45° FOV · 1932 by 1910 pixels.
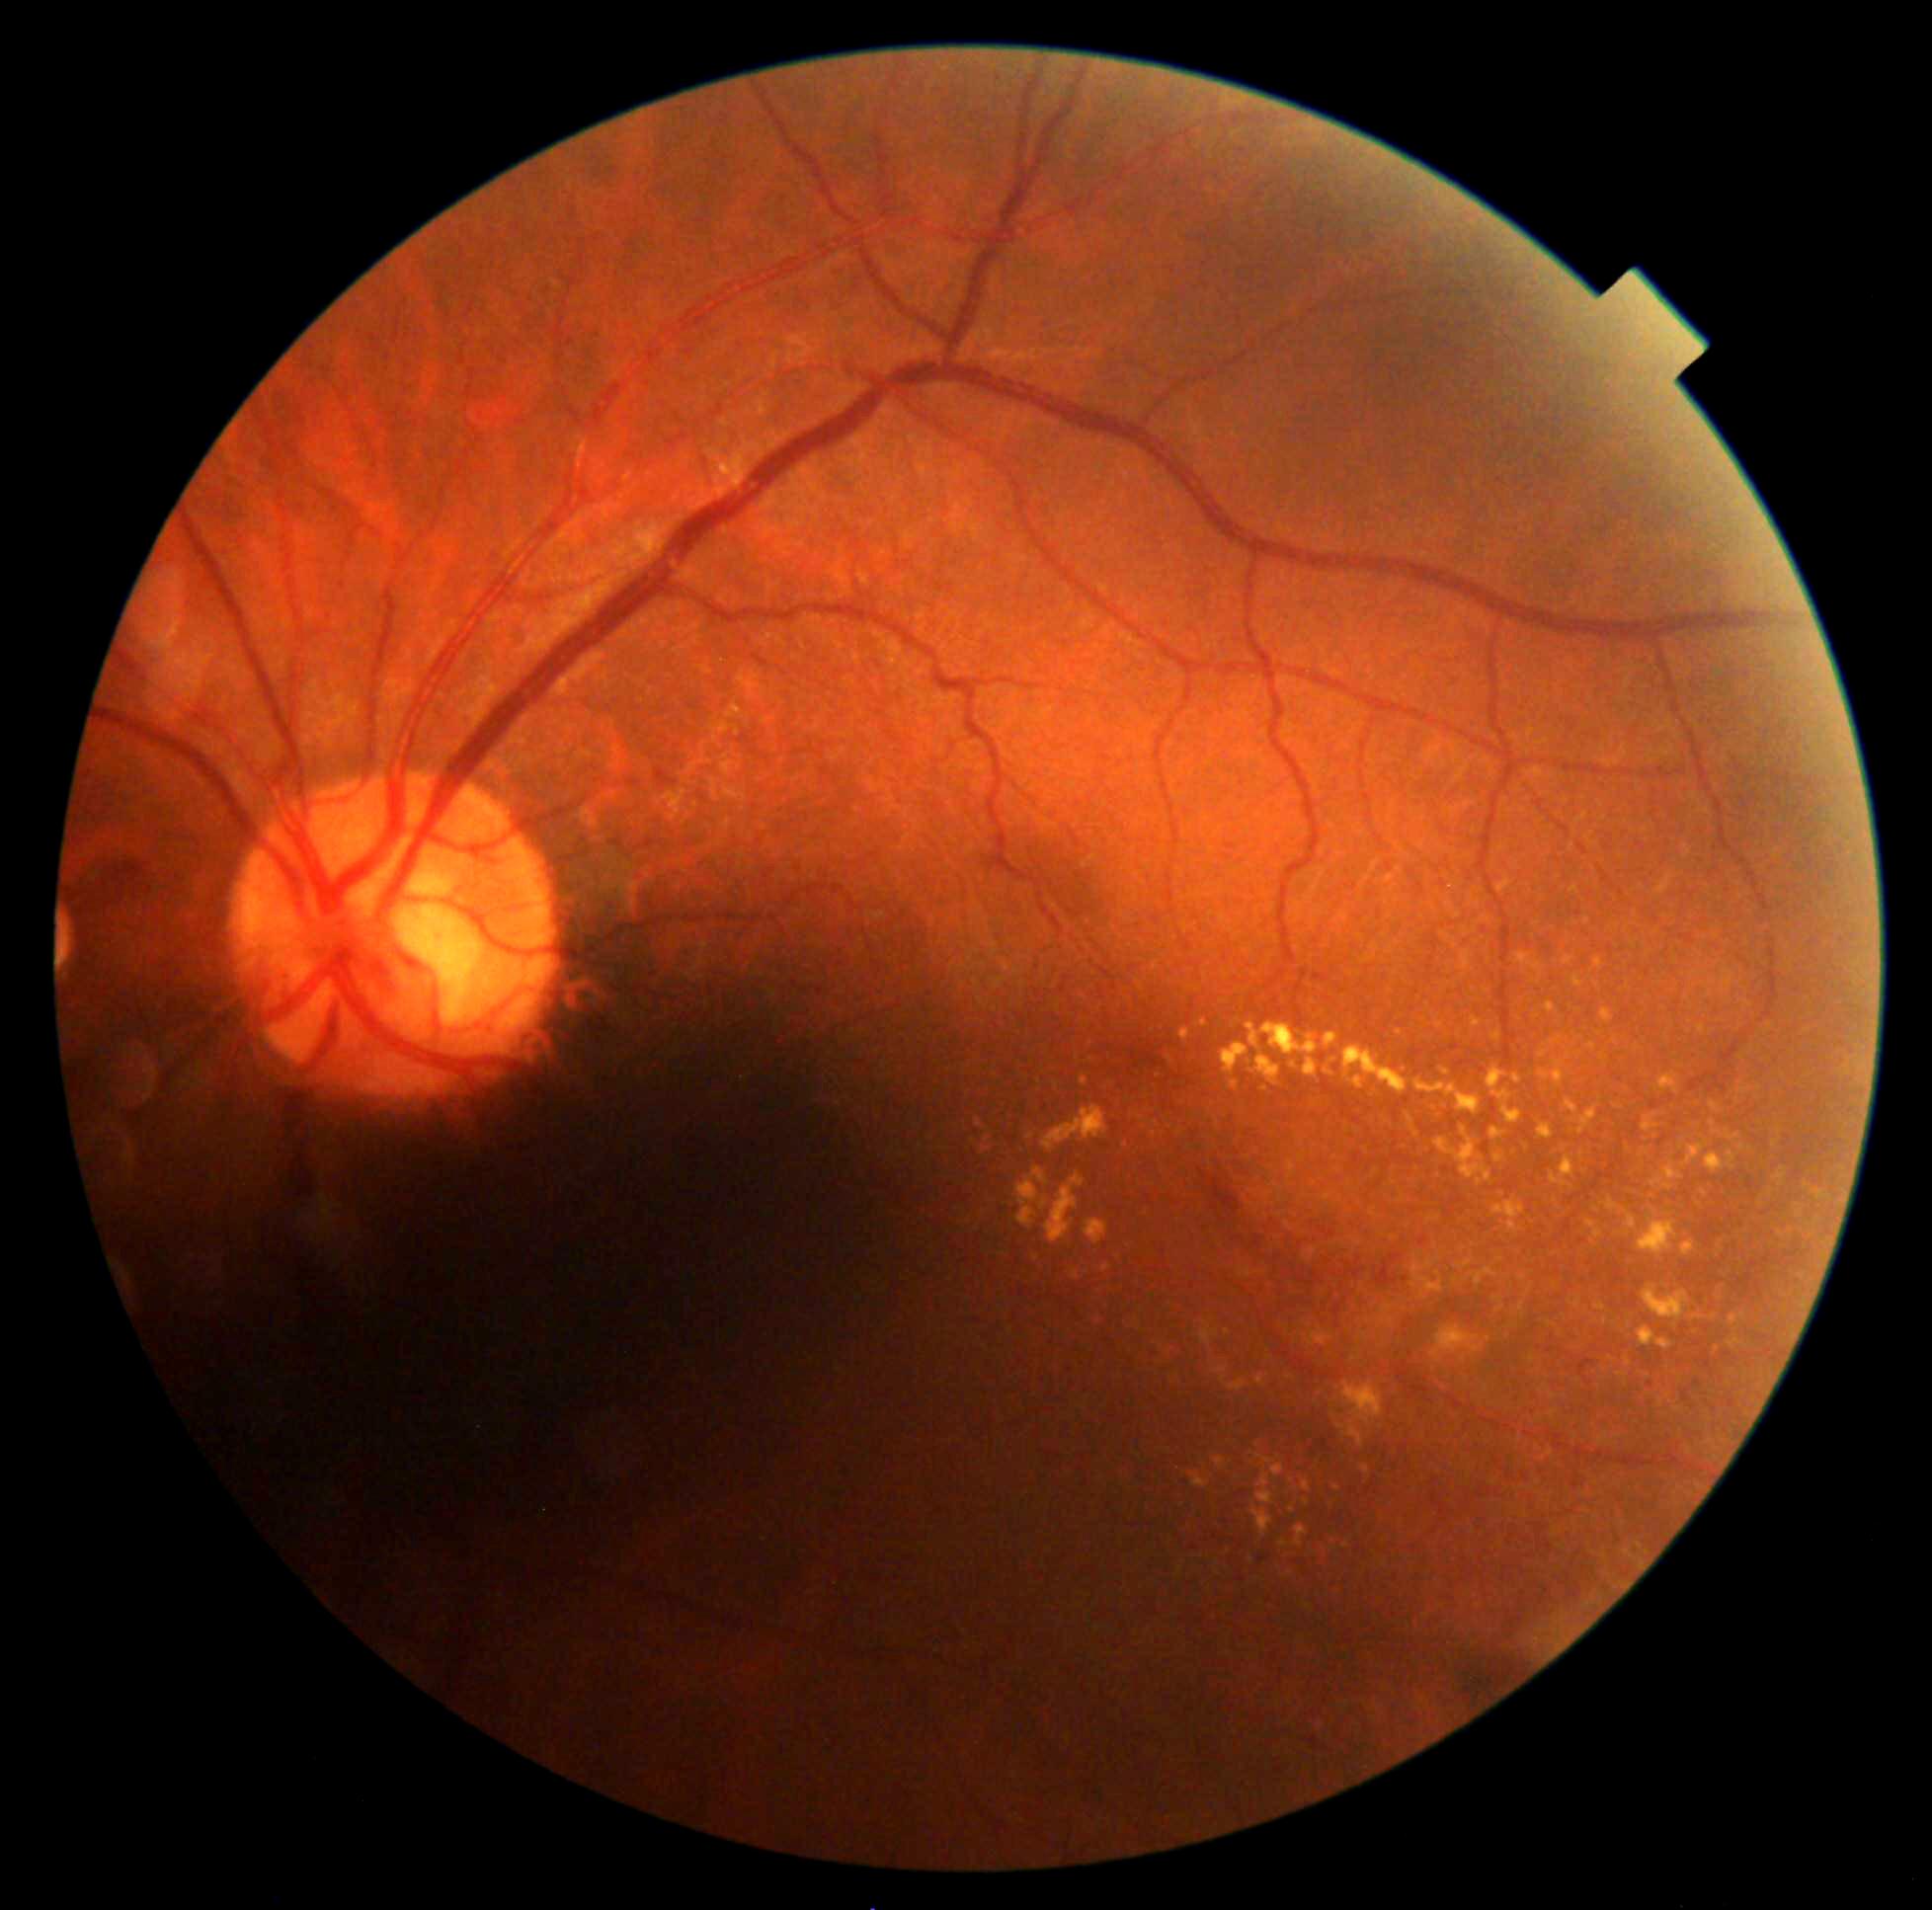

<lesions partial="true">
  <dr_grade>2</dr_grade>
  <ex partial="true">{"left": 1257, "top": 1376, "right": 1266, "bottom": 1389}; {"left": 1682, "top": 1241, "right": 1696, "bottom": 1257}; {"left": 1219, "top": 1378, "right": 1248, "bottom": 1393}; {"left": 1280, "top": 1541, "right": 1289, "bottom": 1548}; {"left": 1472, "top": 1017, "right": 1483, "bottom": 1030}; {"left": 1538, "top": 1125, "right": 1555, "bottom": 1141}; {"left": 1221, "top": 1042, "right": 1249, "bottom": 1077}; {"left": 1304, "top": 1481, "right": 1311, "bottom": 1492}; {"left": 1253, "top": 1504, "right": 1273, "bottom": 1537}; {"left": 1487, "top": 1066, "right": 1522, "bottom": 1125}; {"left": 1440, "top": 1068, "right": 1450, "bottom": 1076}</ex>
  <ex_small_centers>(1154,1135); (1704,1193); (1602,1058); (1718,1350); (1337,1489); (1303,1155); (1269,1358); (1400,1033)</ex_small_centers>
</lesions>